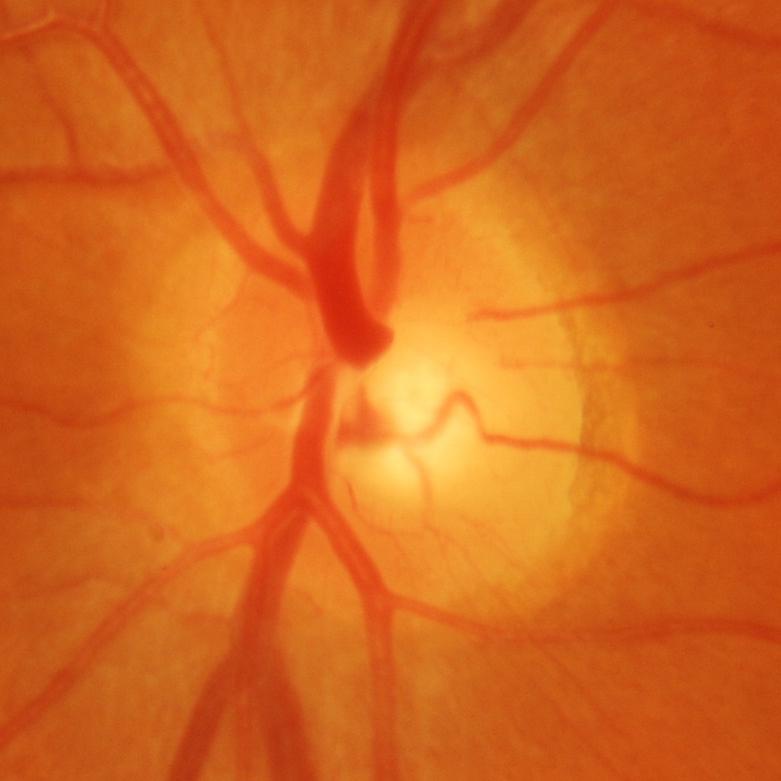

Glaucoma status = glaucomatous damage to the optic nerve.